Posterior pole photograph · 848 x 848 pixels · nonmydriatic · NIDEK AFC-230 fundus camera:
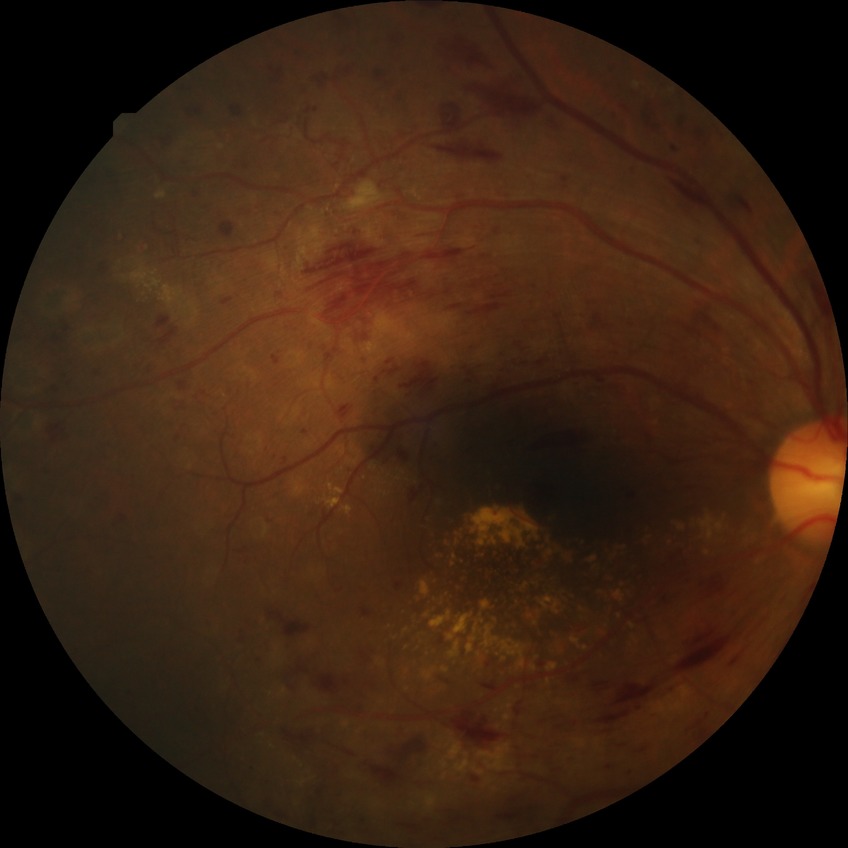

  davis_grade: proliferative diabetic retinopathy